1932x1932. Pupil-dilated: 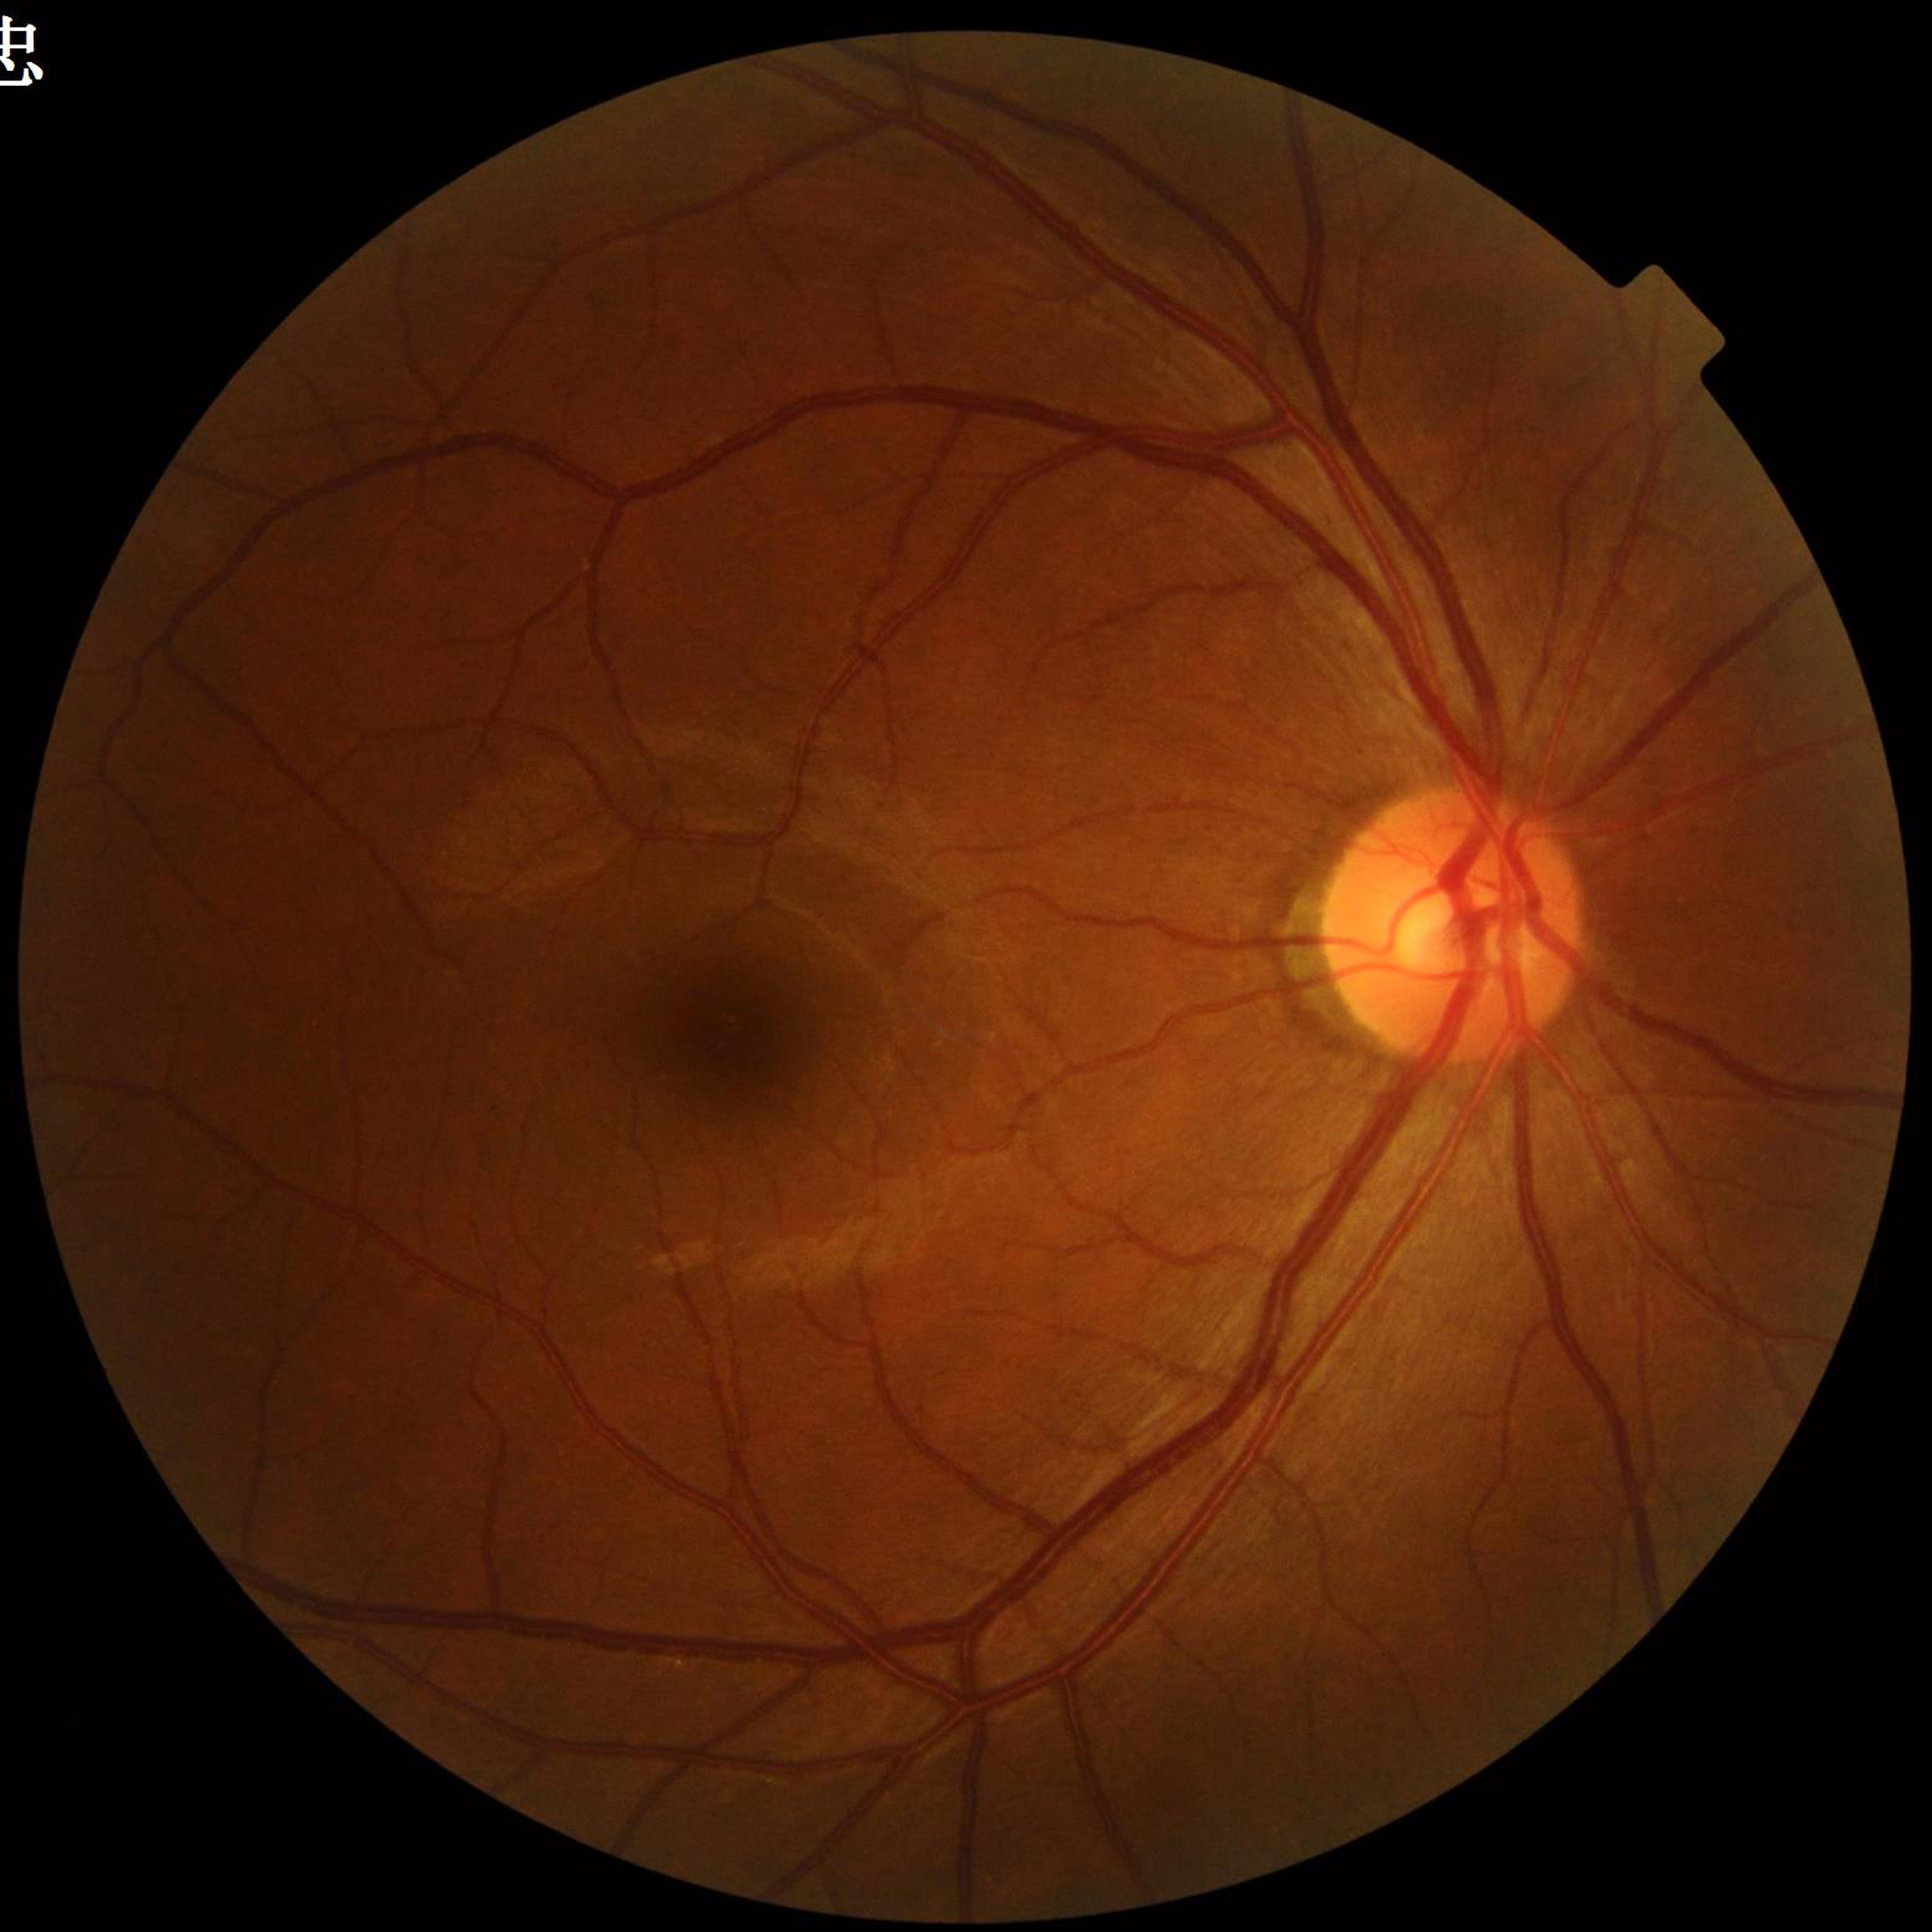
Photo quality: adequate. Fundus image of an eye with diabetic retinopathy.